Camera: NIDEK AFC-230, nonmydriatic, 848x848px — 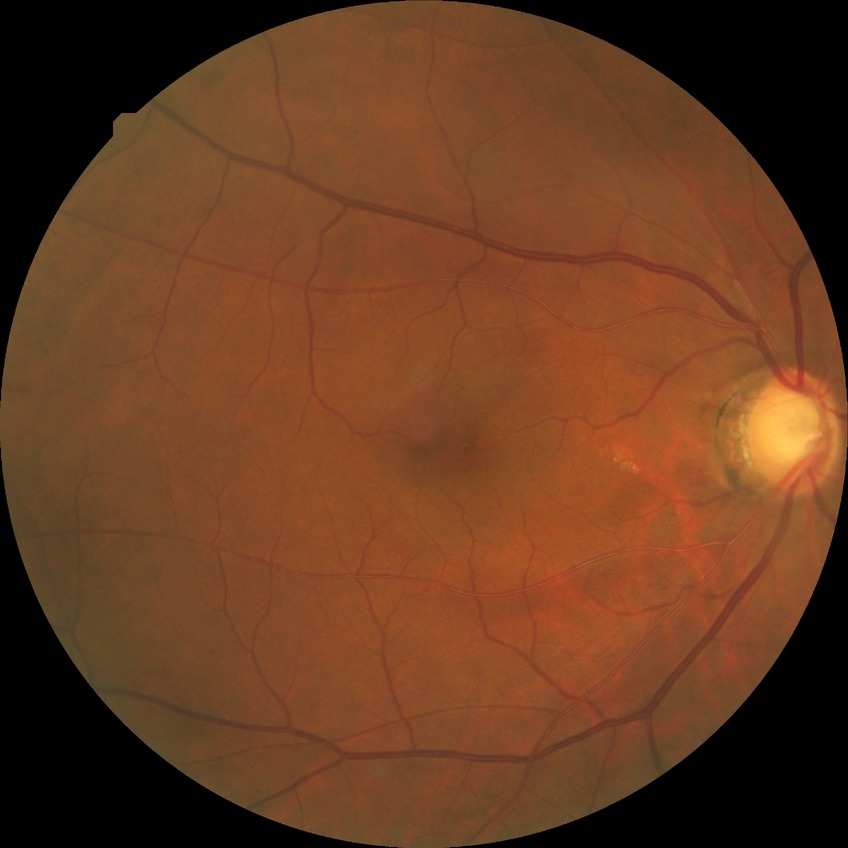
Diabetic retinopathy (DR) is pre-proliferative diabetic retinopathy (PPDR). The retinopathy is classified as non-proliferative diabetic retinopathy.